IOP 19 mmHg (Perkins applanation tonometry) · axial length (AL) 23.6 mm · optic disc at the center of the field · 30° FOV · 63-year-old patient · autorefraction: -1.25 -1.25 × 125° · sex: M · 2212x1661 — 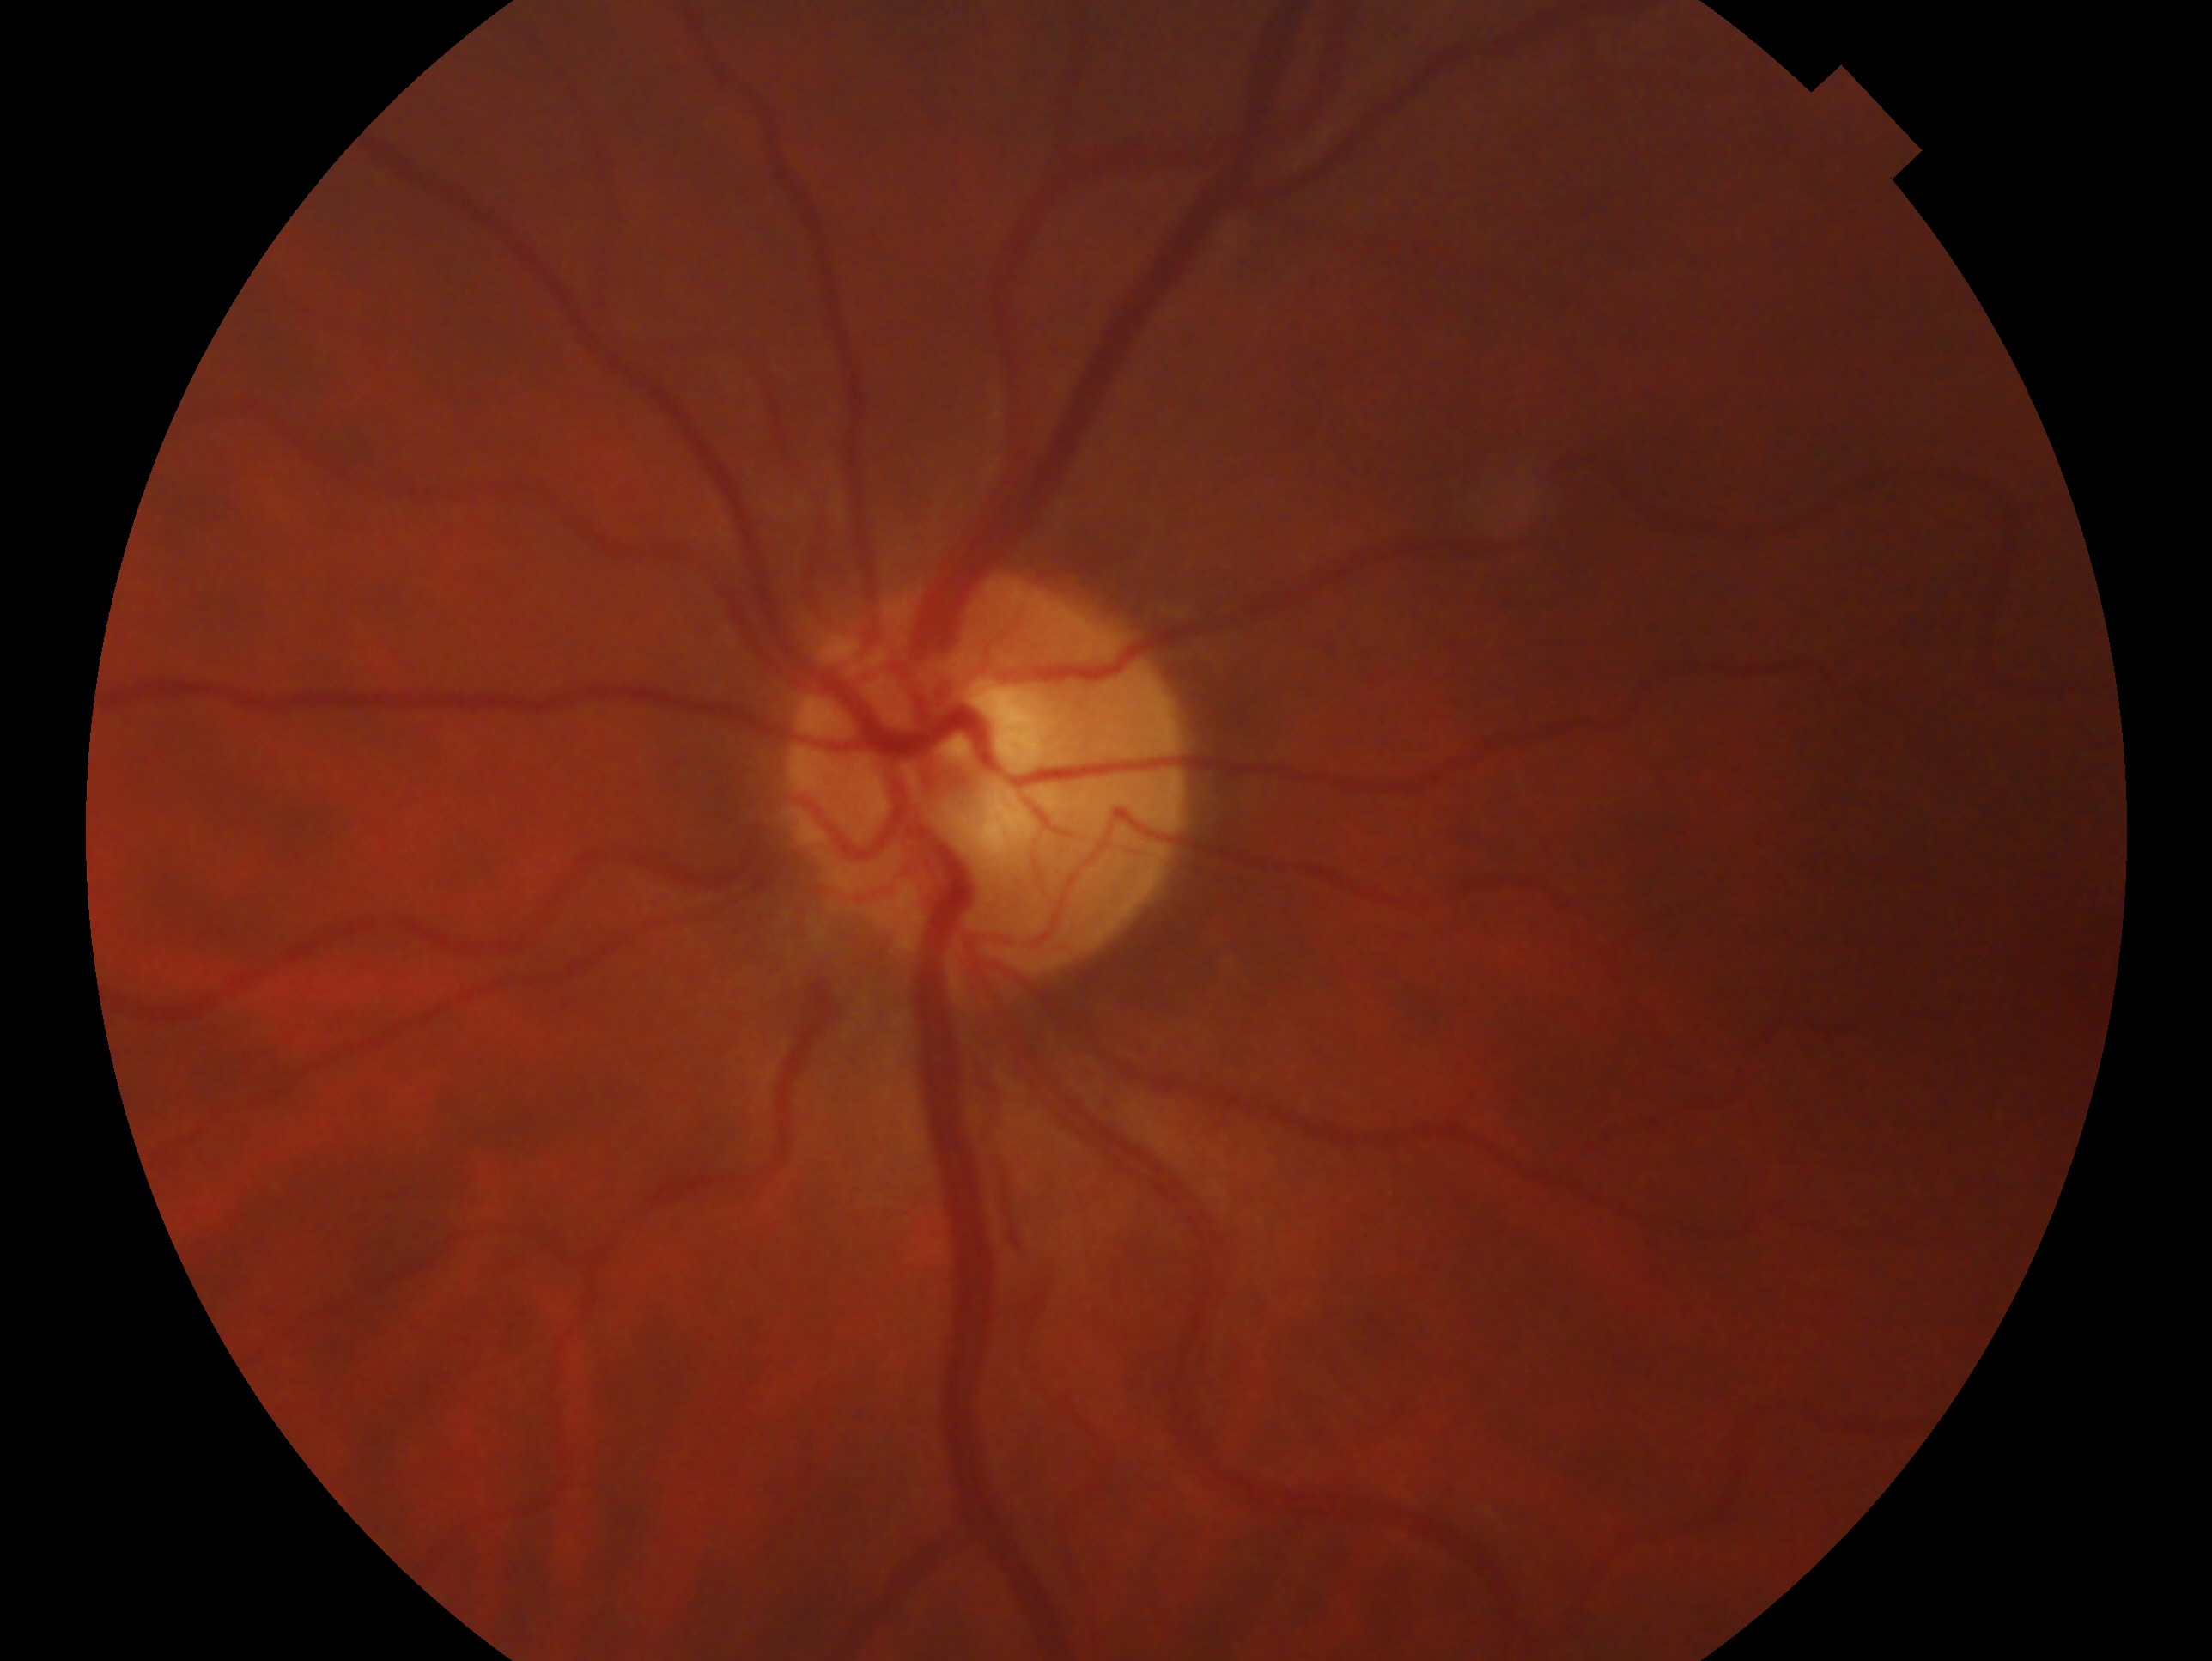 The image shows the left eye. Assessment: suspicious for glaucoma.